100° field of view (Phoenix ICON); 1240x1240px; pediatric wide-field fundus photograph — 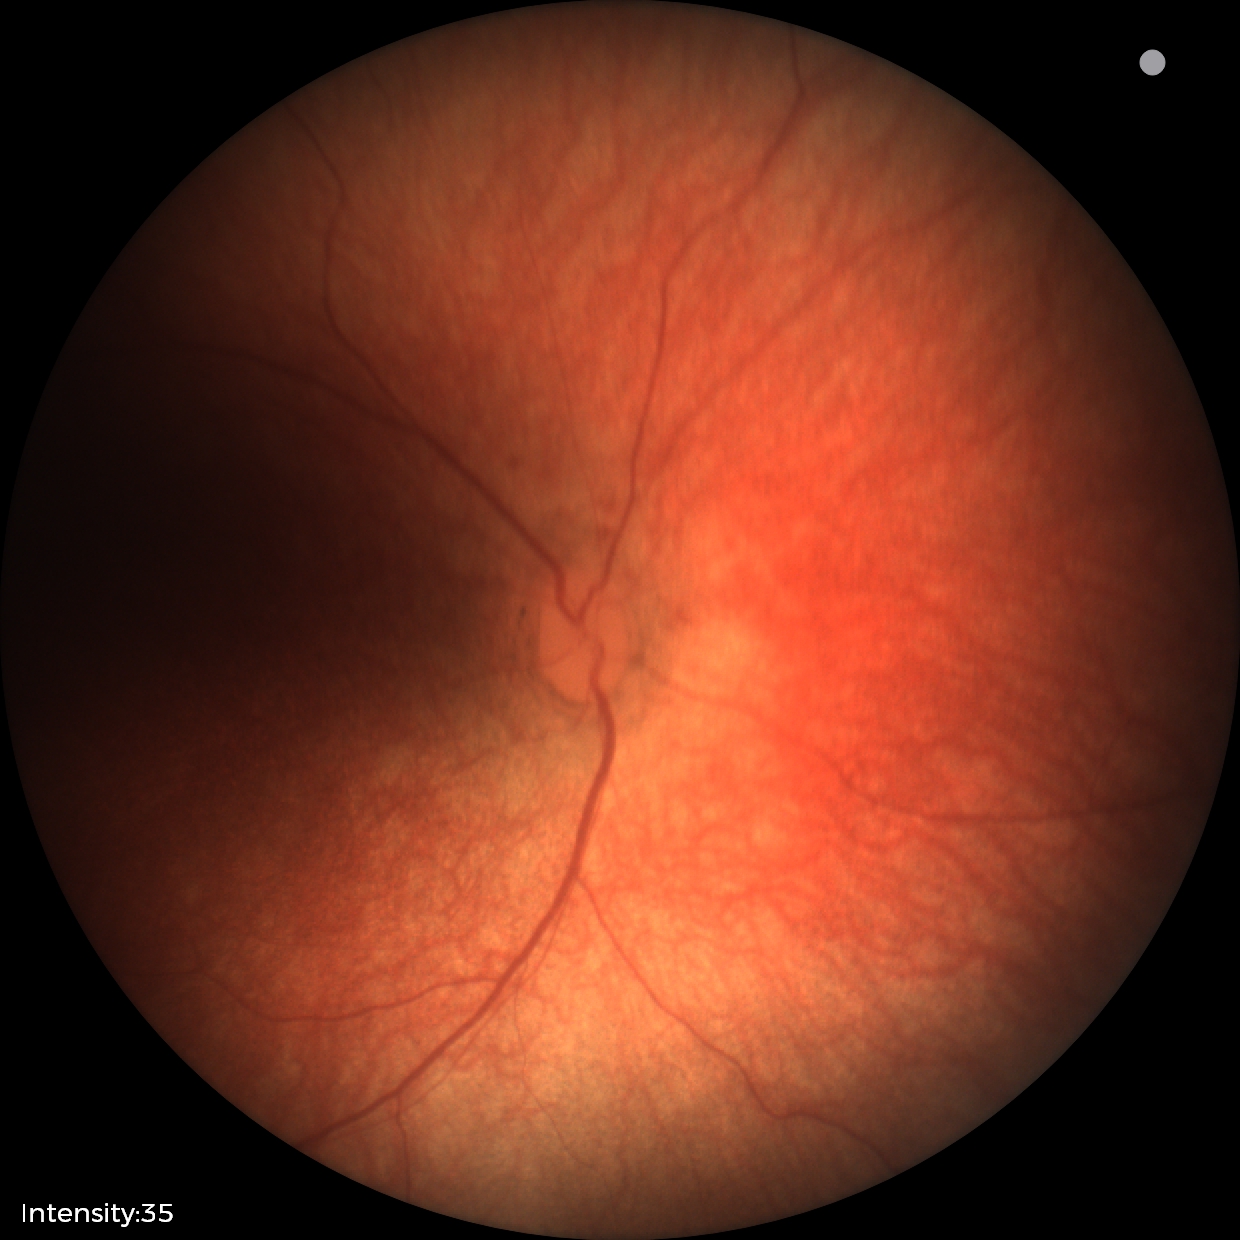

Screening examination with no abnormal retinal findings.